848x848px · NIDEK AFC-230 fundus camera · posterior pole color fundus photograph
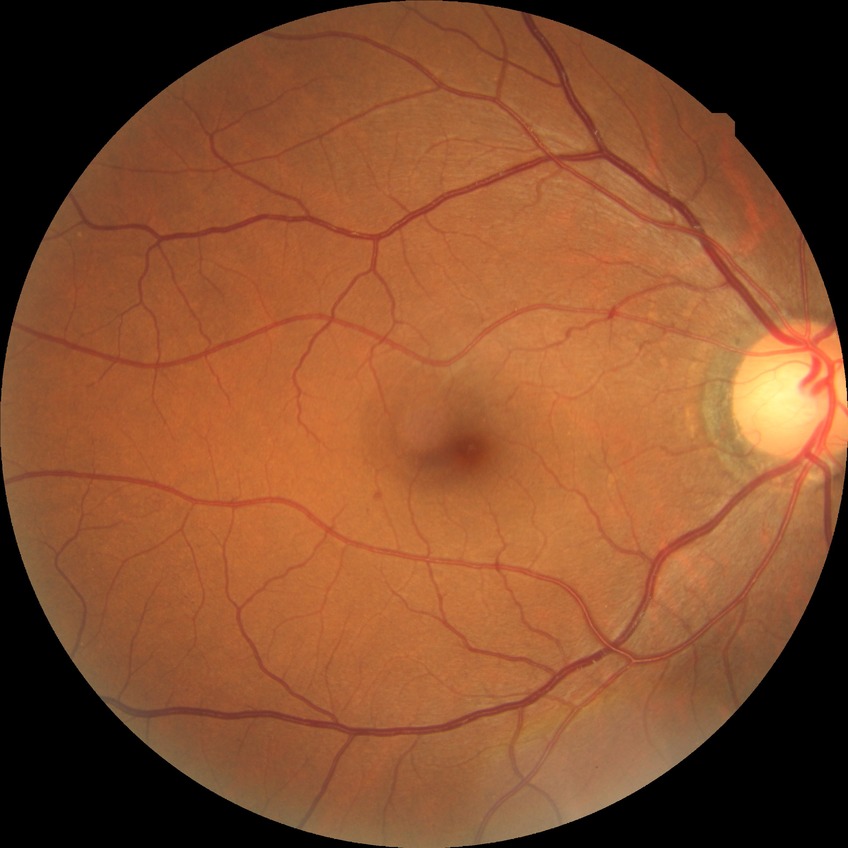

Findings:
• diabetic retinopathy grade — no diabetic retinopathy